Wide-field fundus photograph of an infant
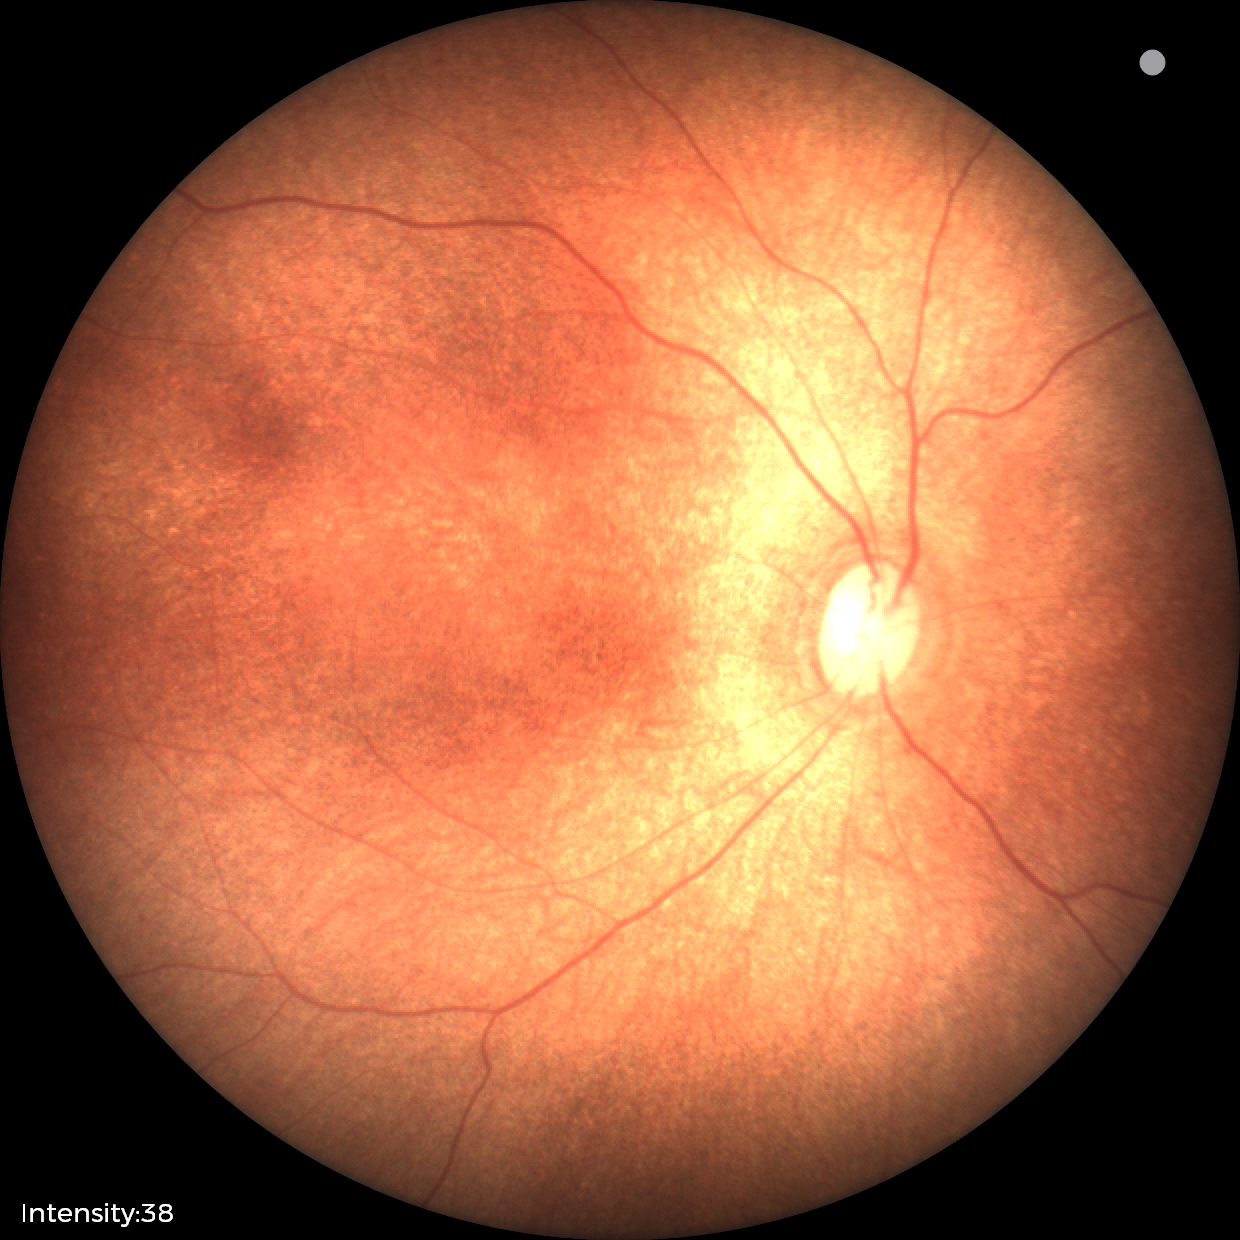
Q: What is the screening diagnosis?
A: normal retinal appearance